Captured with the Phoenix ICON (100° field of view) · wide-field fundus photograph of an infant · 1240 x 1240 pixels — 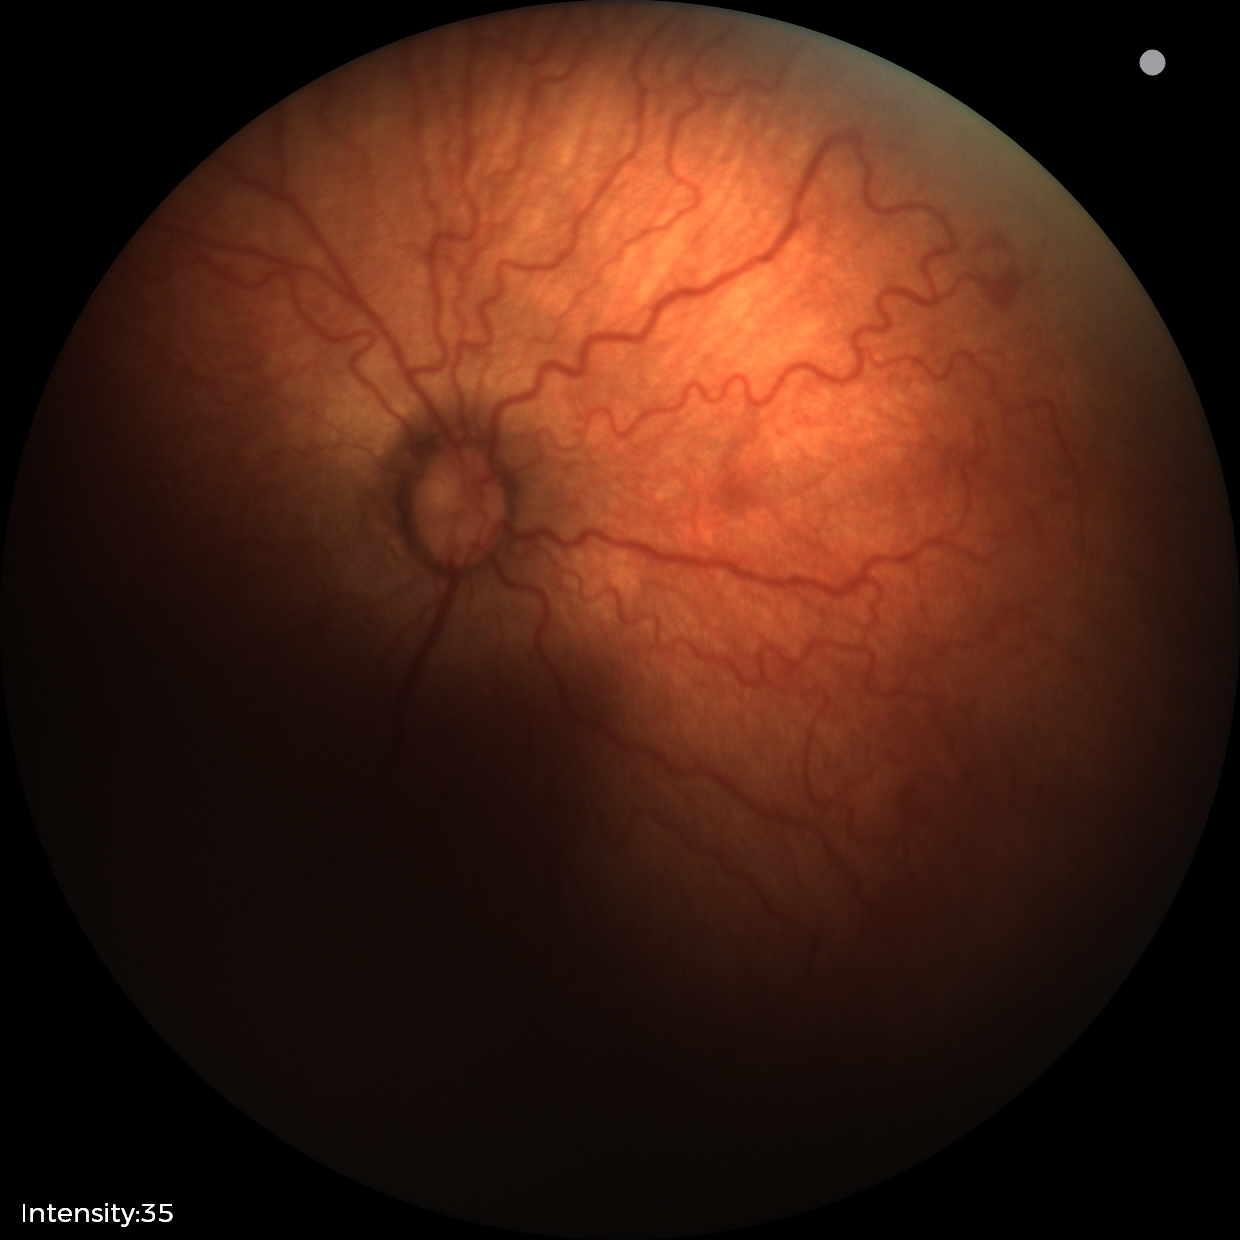

Plus disease was diagnosed.
Examination diagnosed as ROP stage 2.